848x848px. Nonmydriatic — 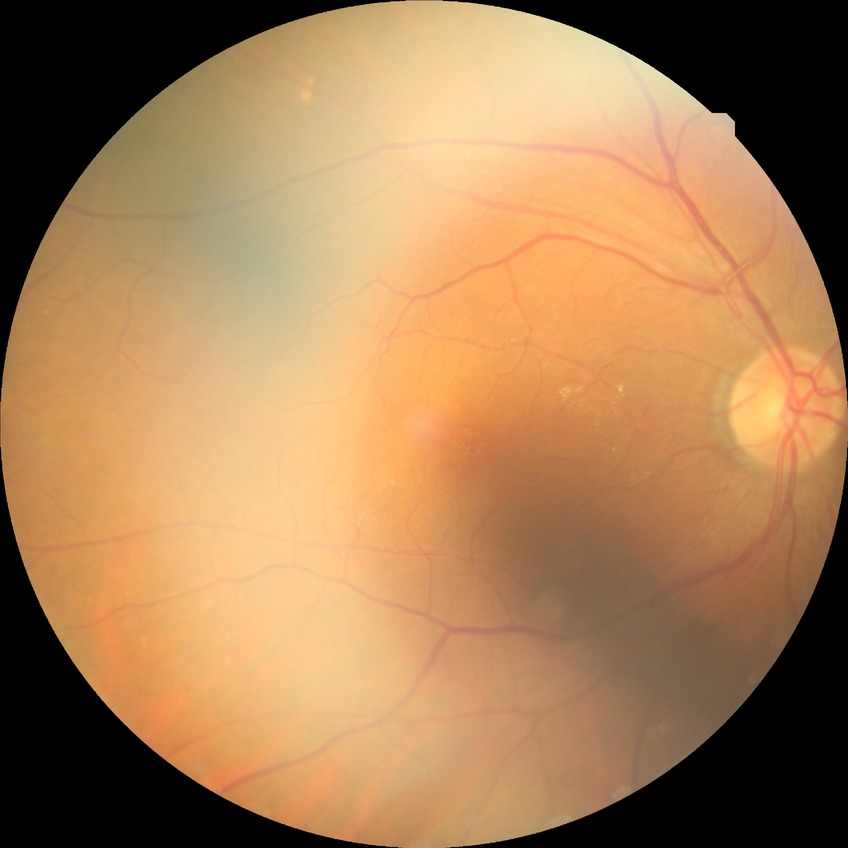

retinopathy stage: no diabetic retinopathy.